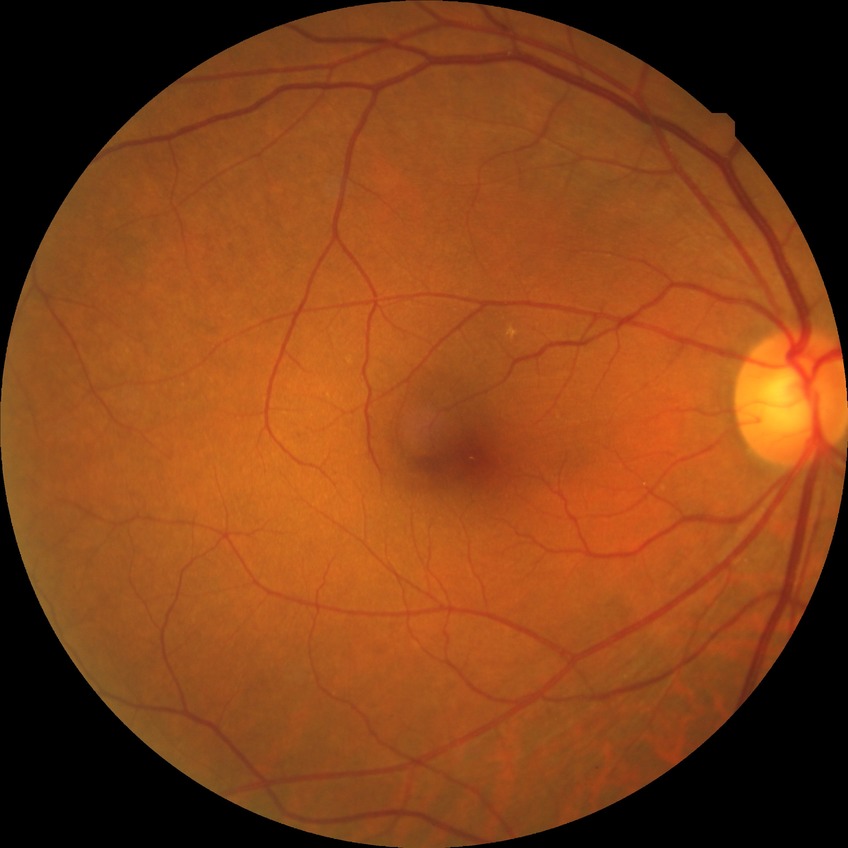

Annotations:
• diabetic retinopathy (DR): NDR (no diabetic retinopathy)